Image size 2352x1568
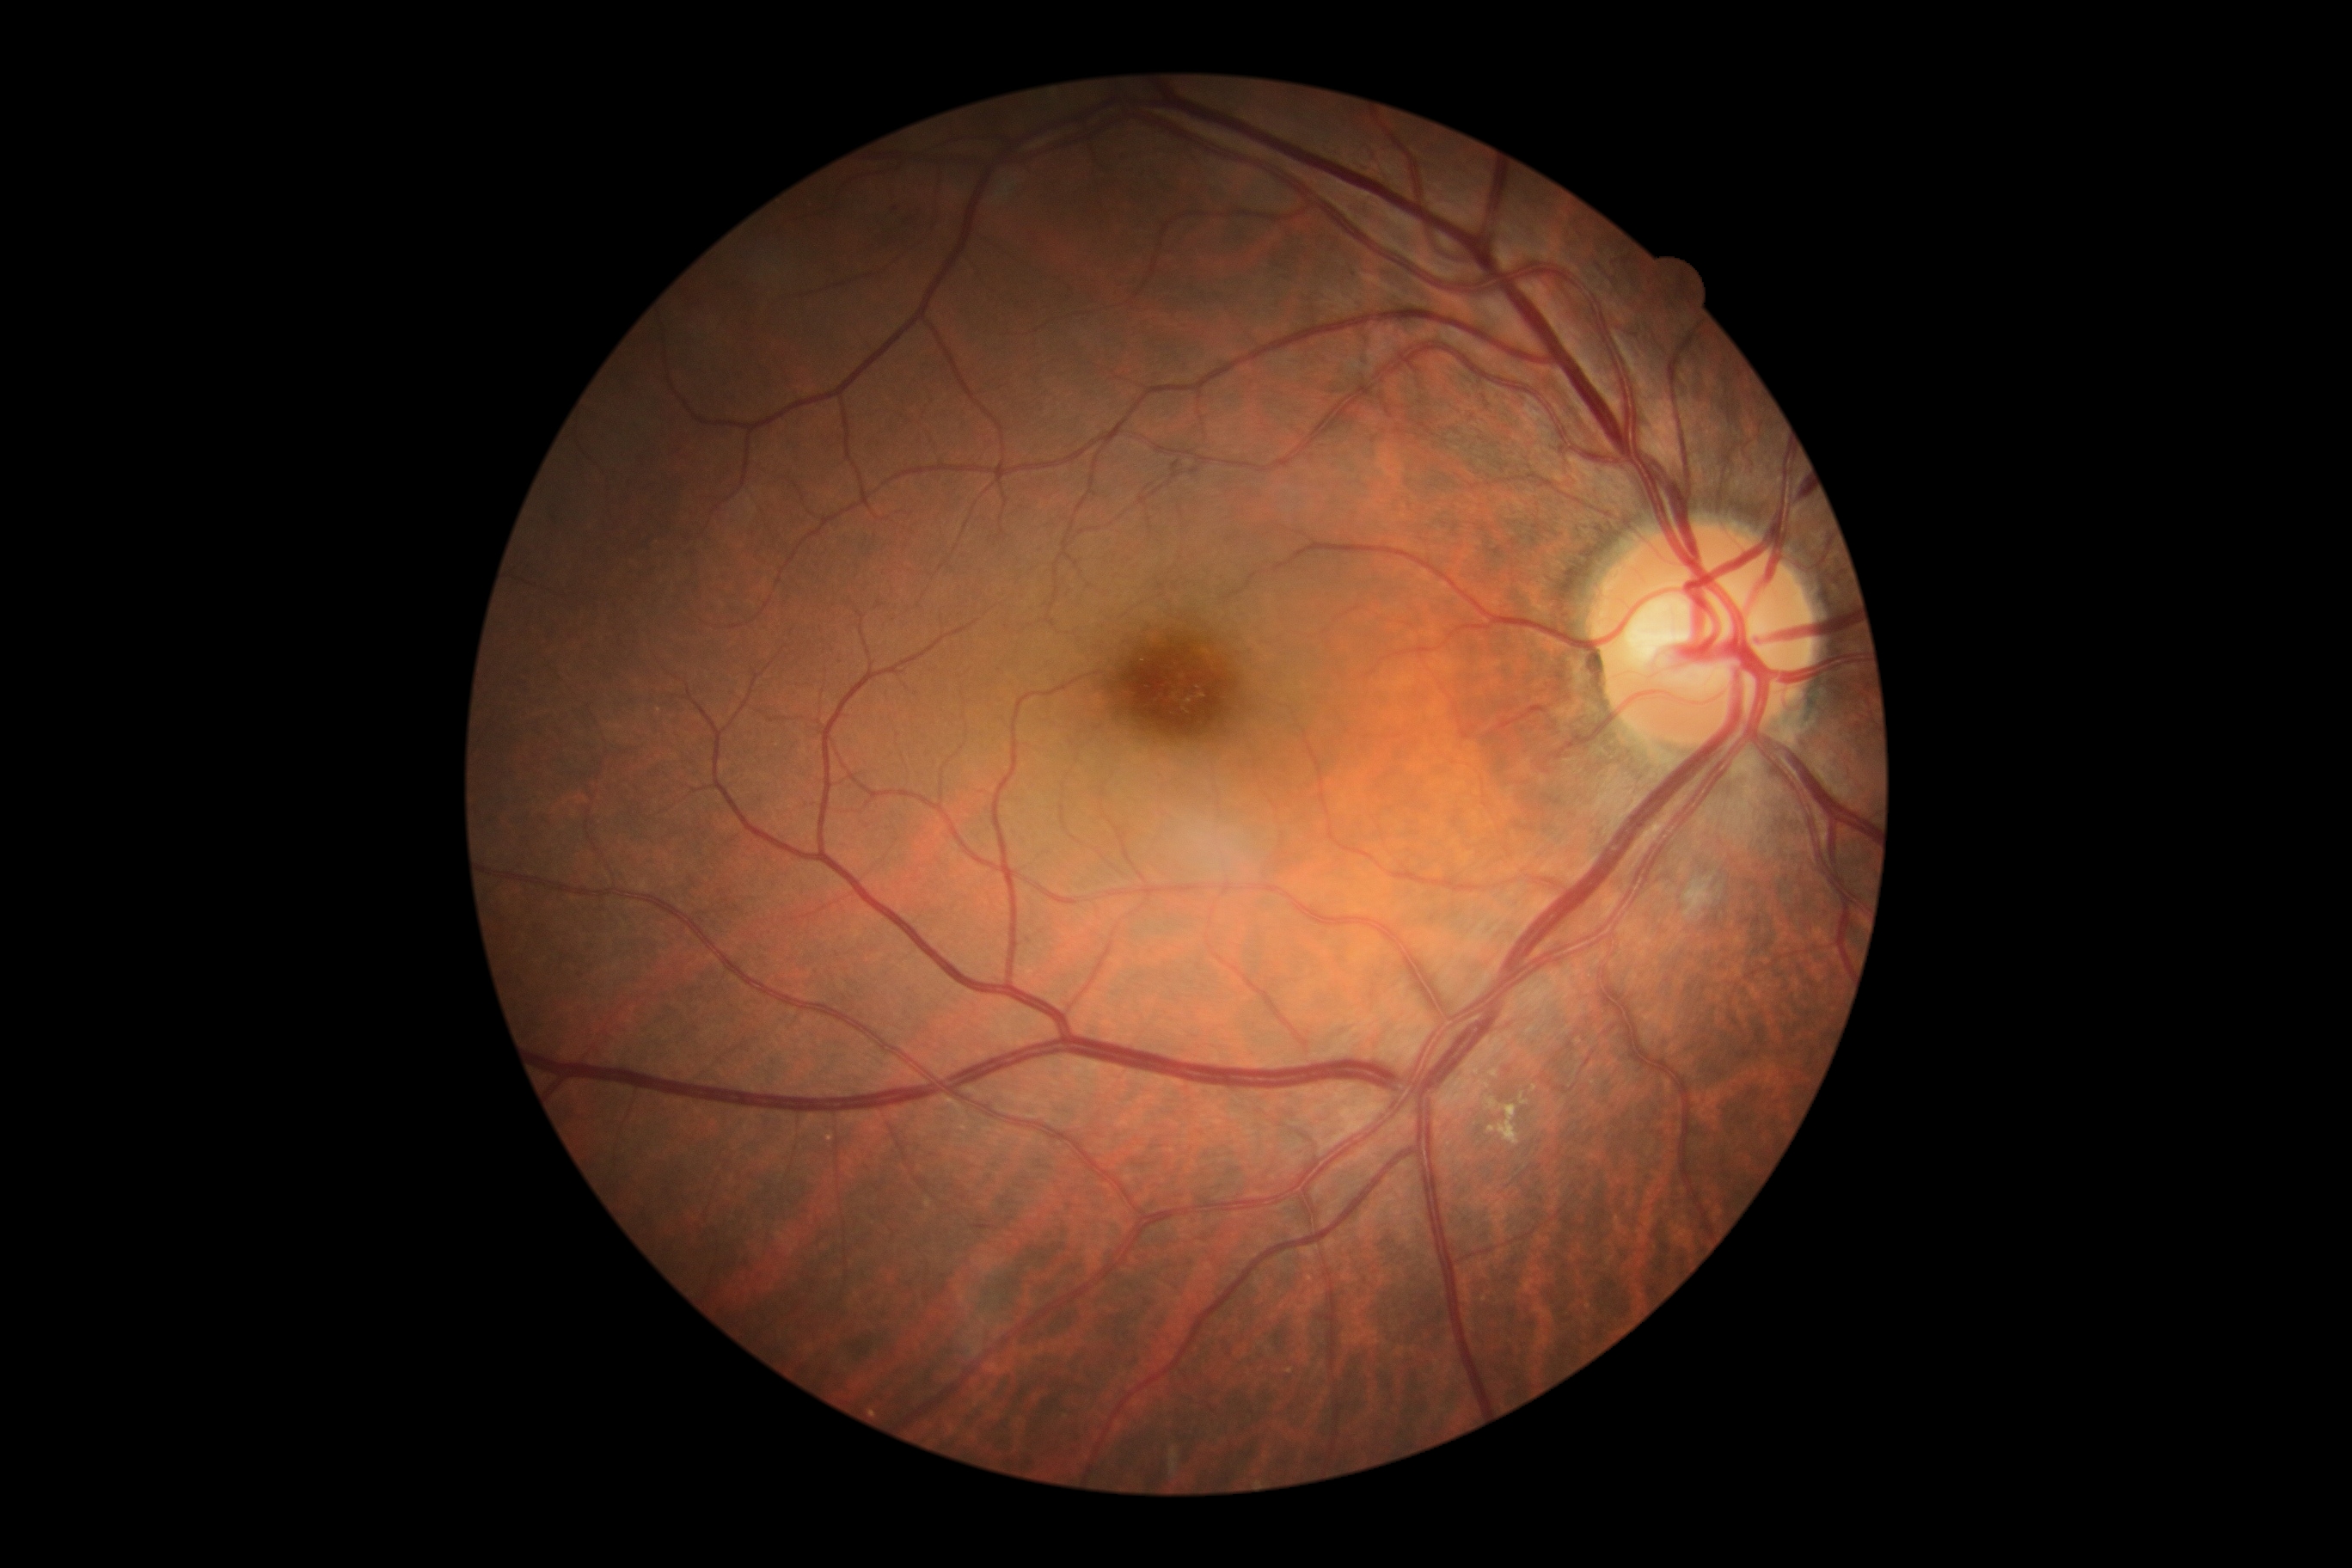 DR severity is grade 2 (moderate NPDR).